Color fundus photograph.
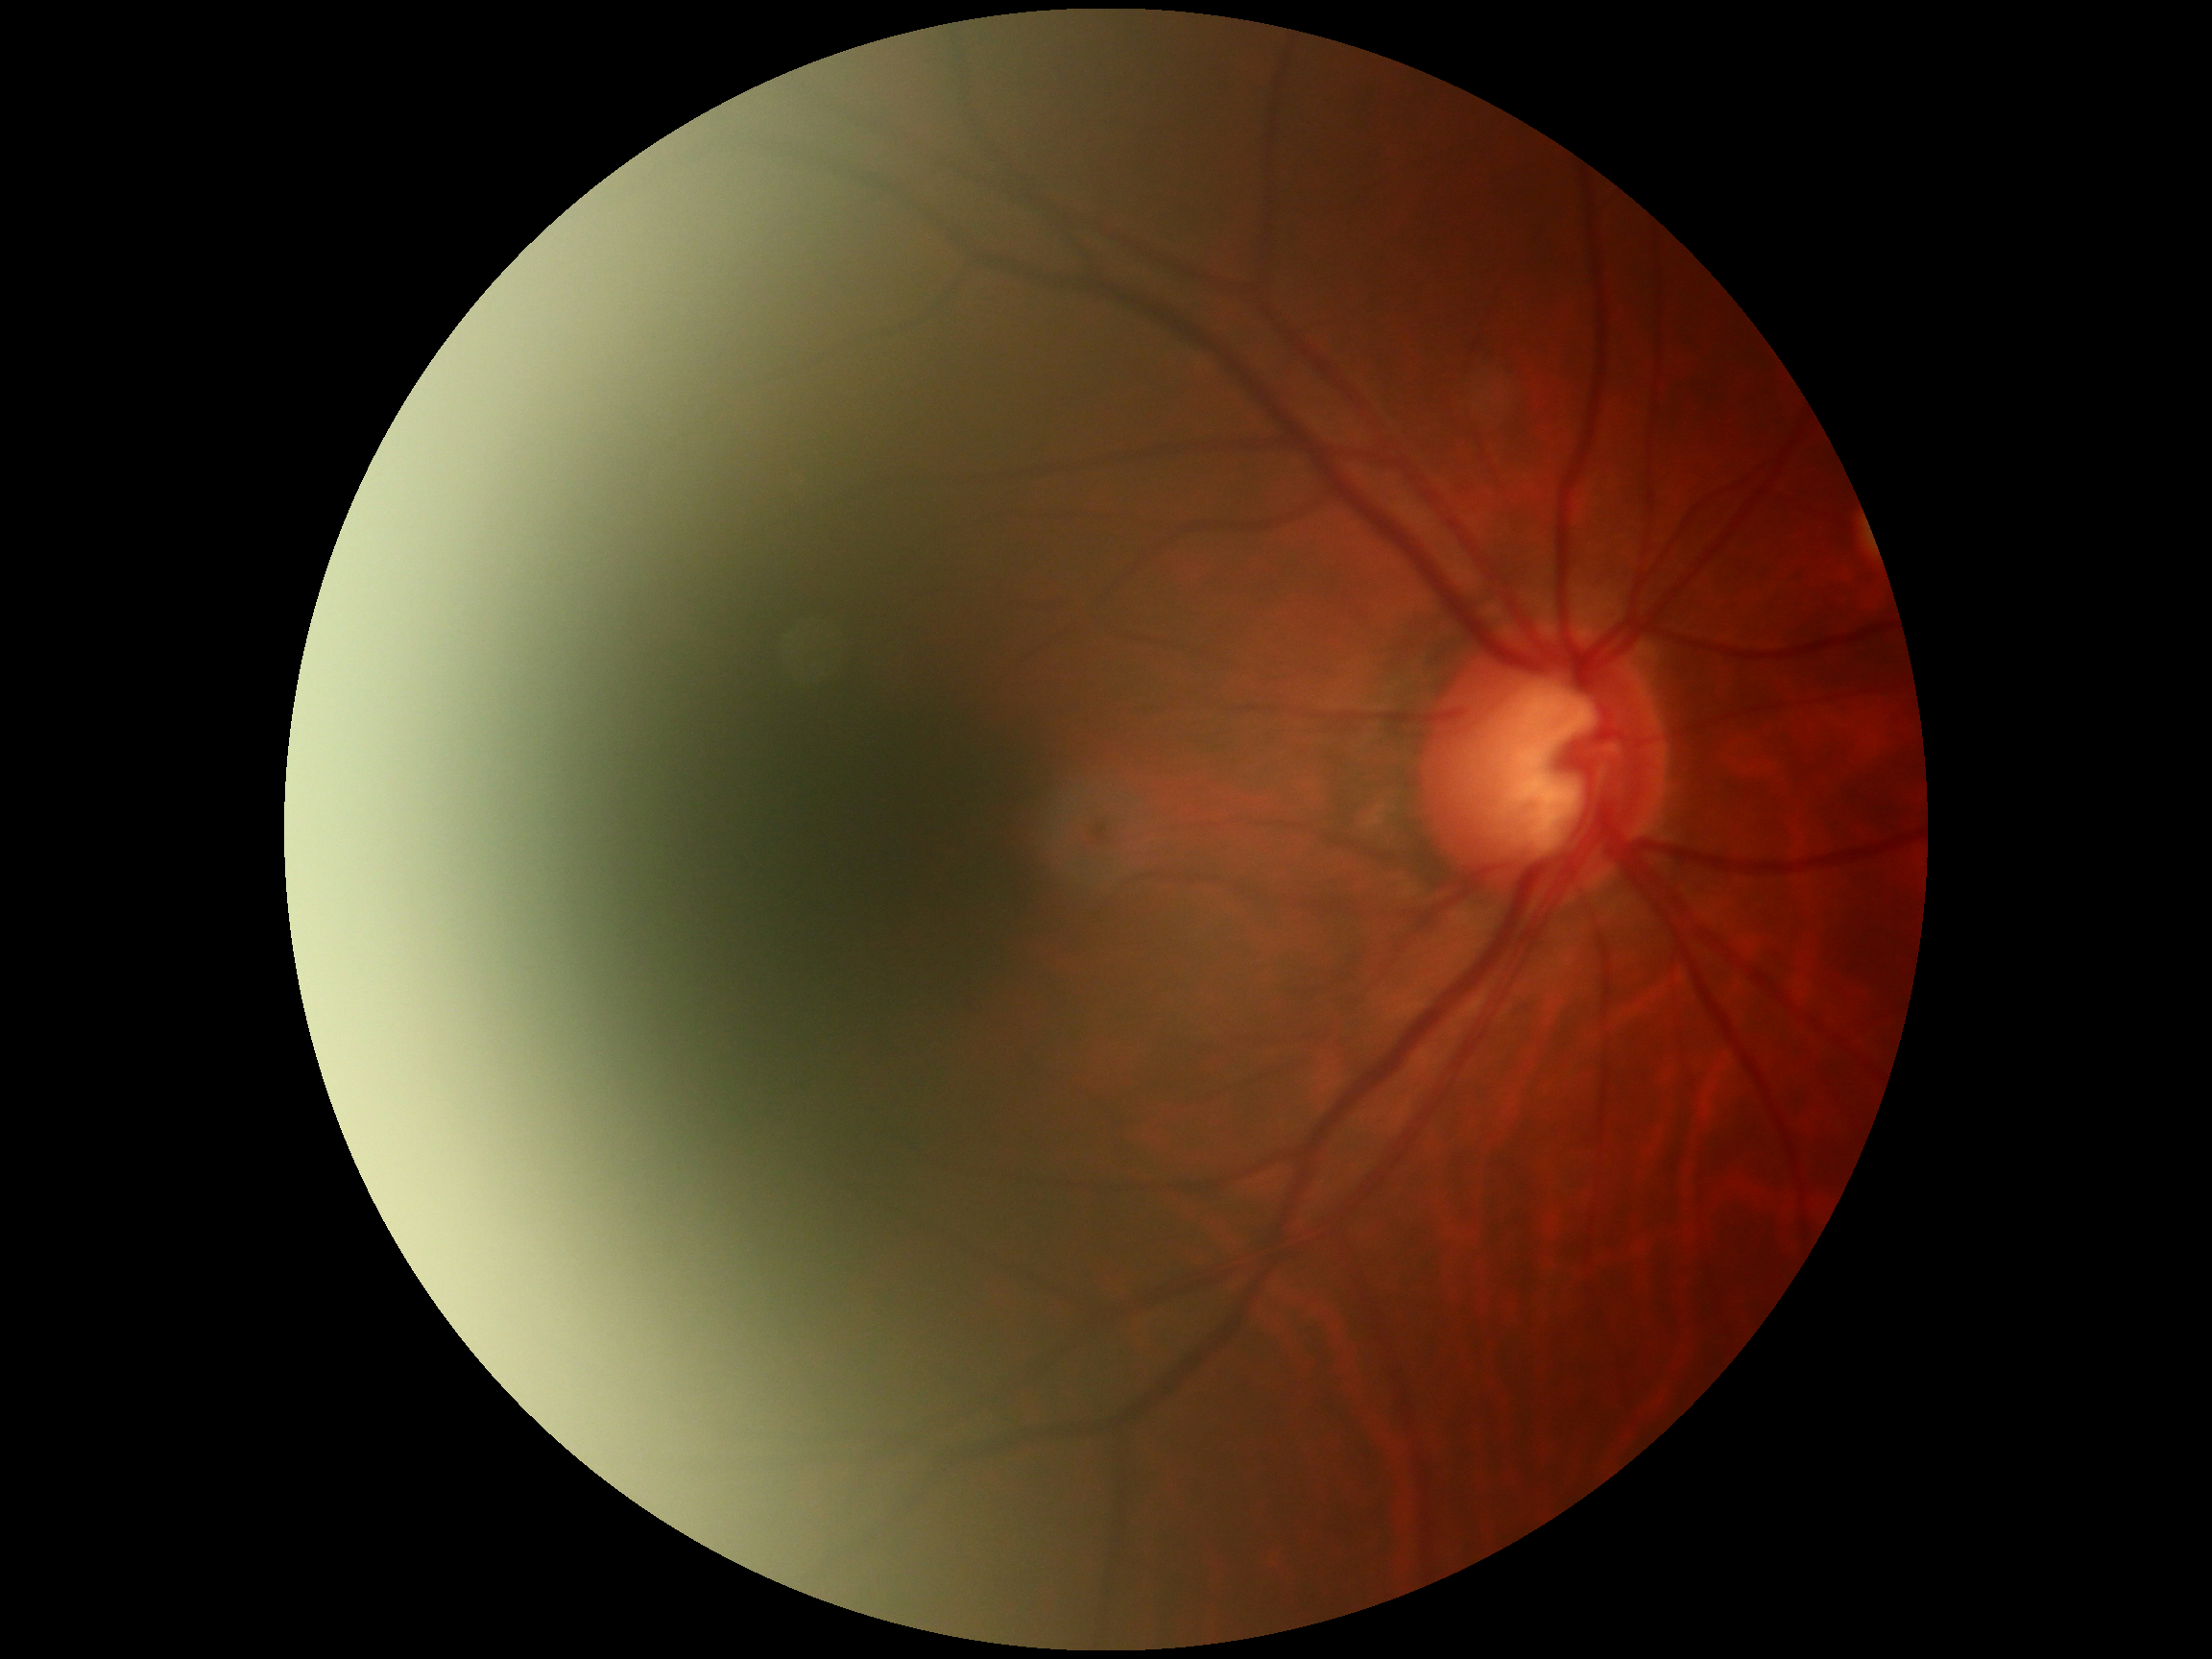

diabetic retinopathy (DR)=grade 0 (no apparent retinopathy).